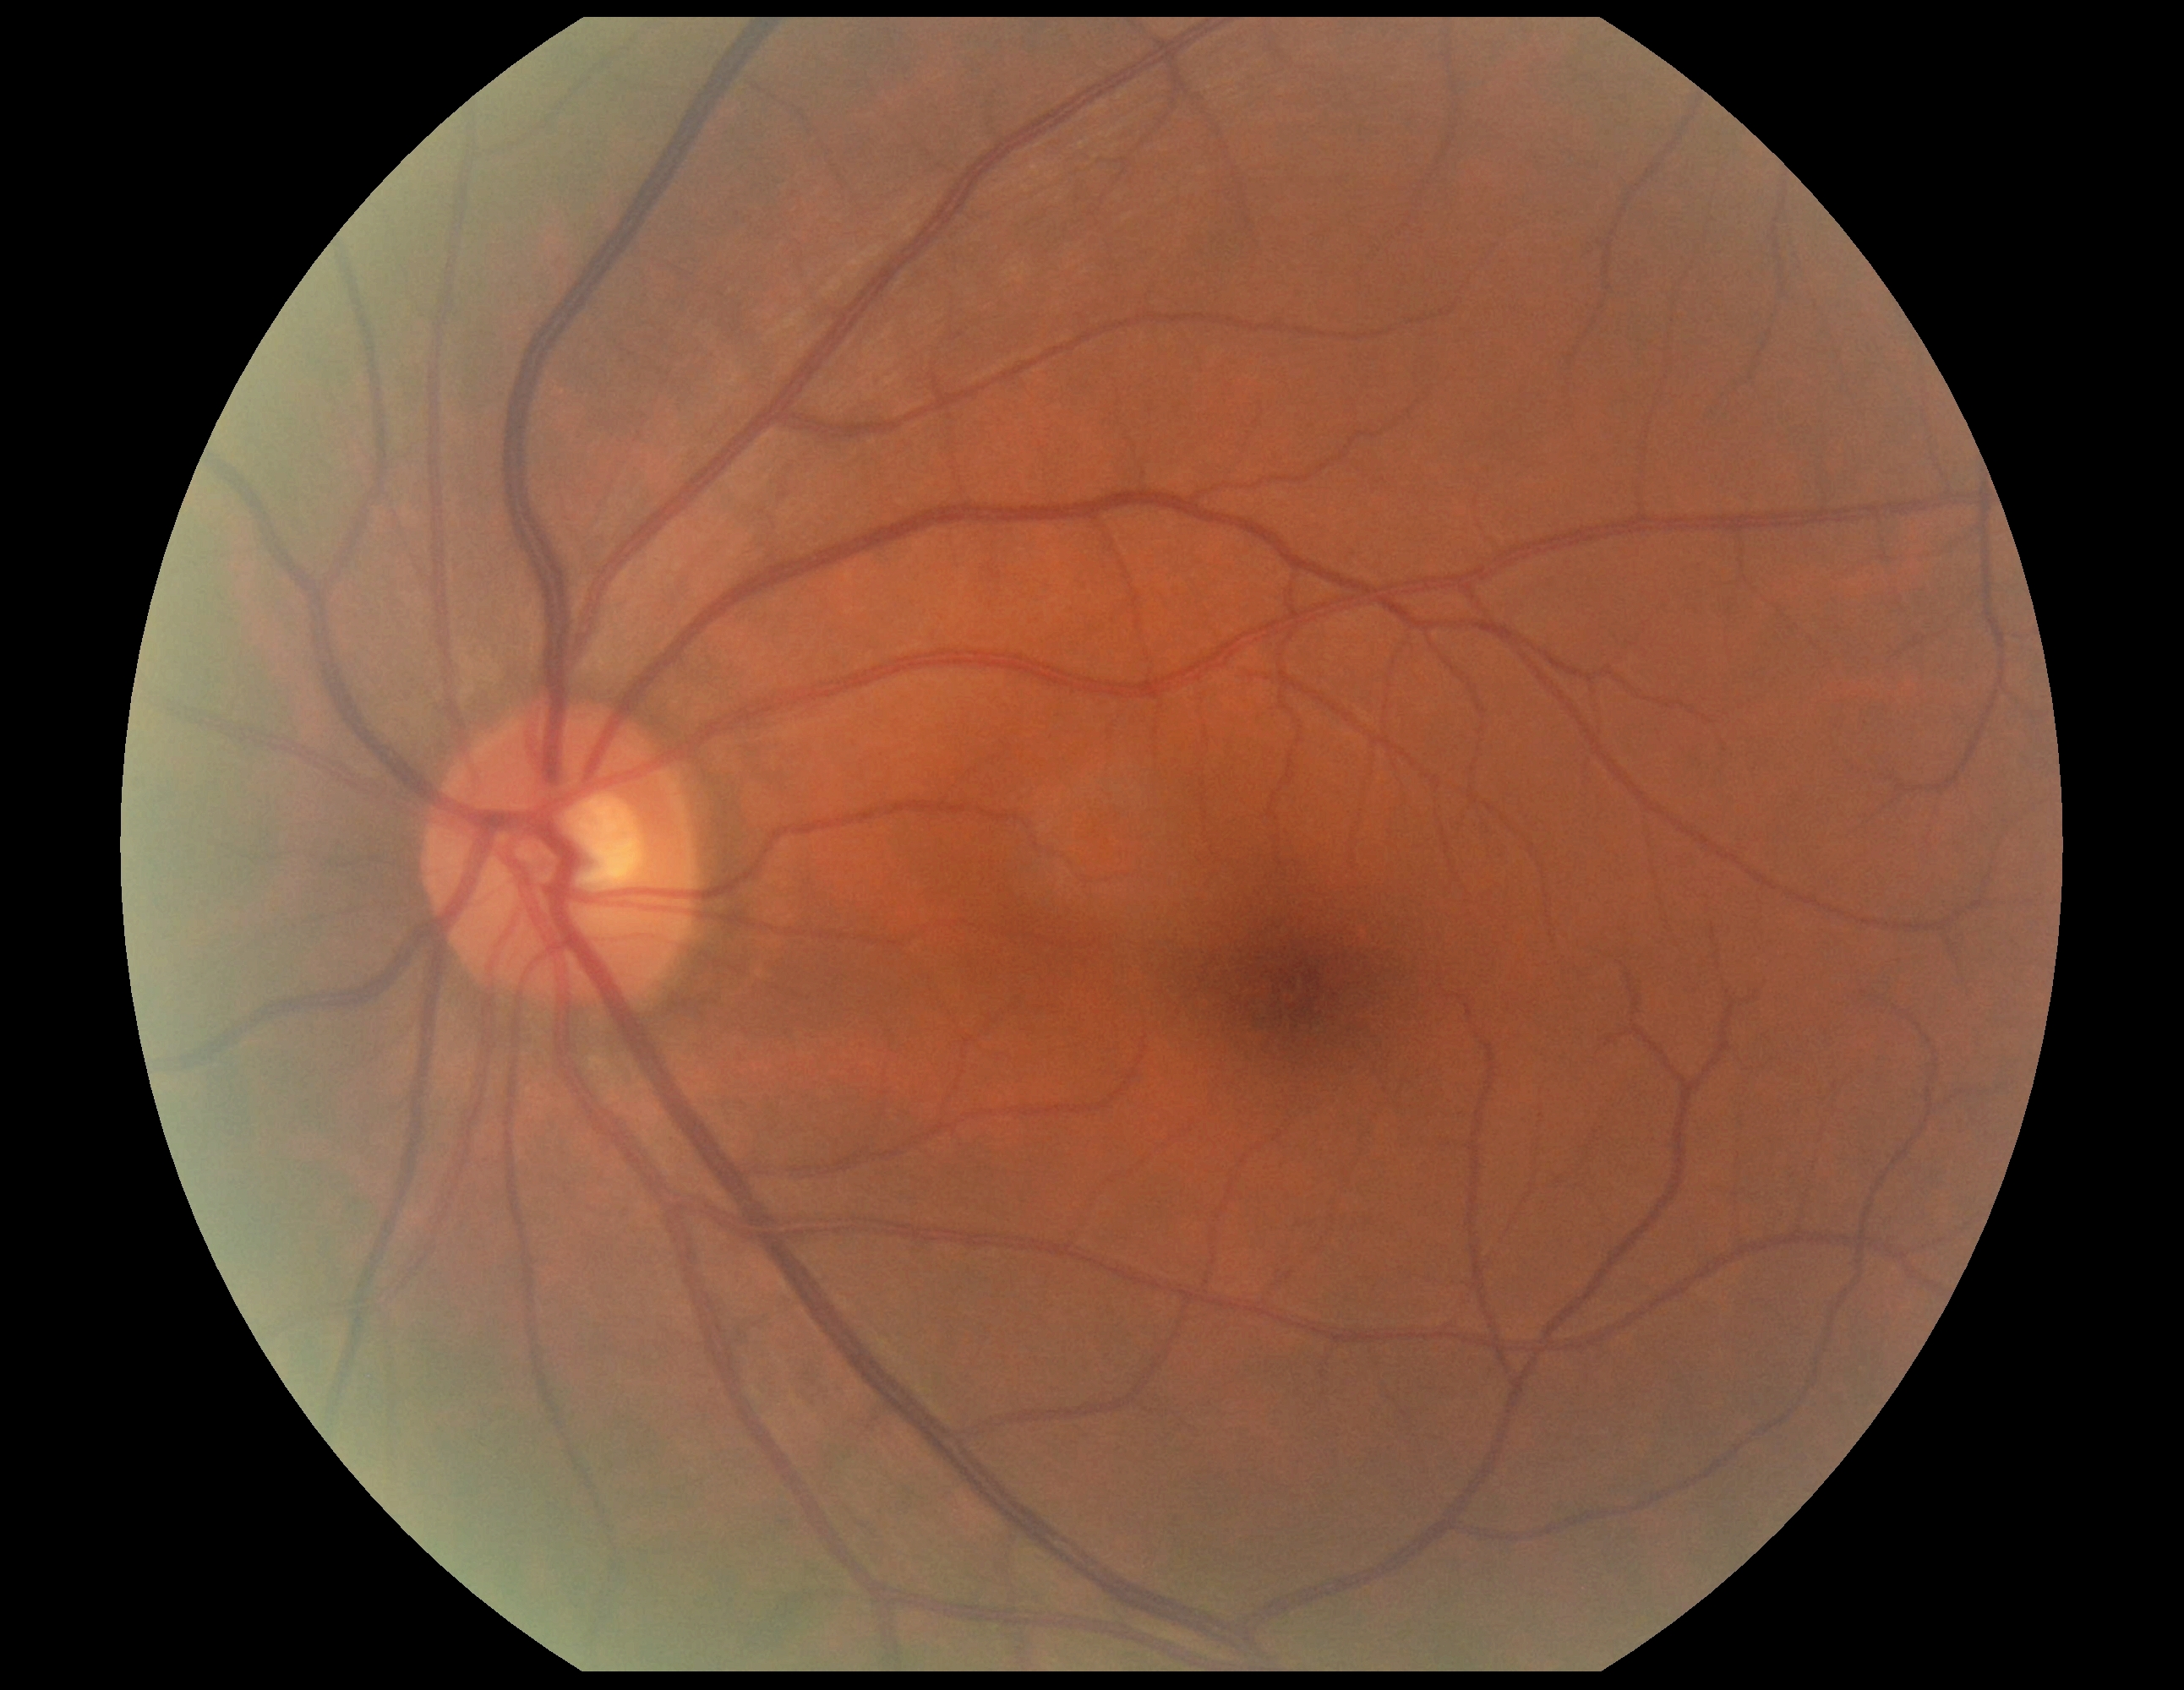

DR grade is 0/4.